NIDEK AFC-230 fundus camera.
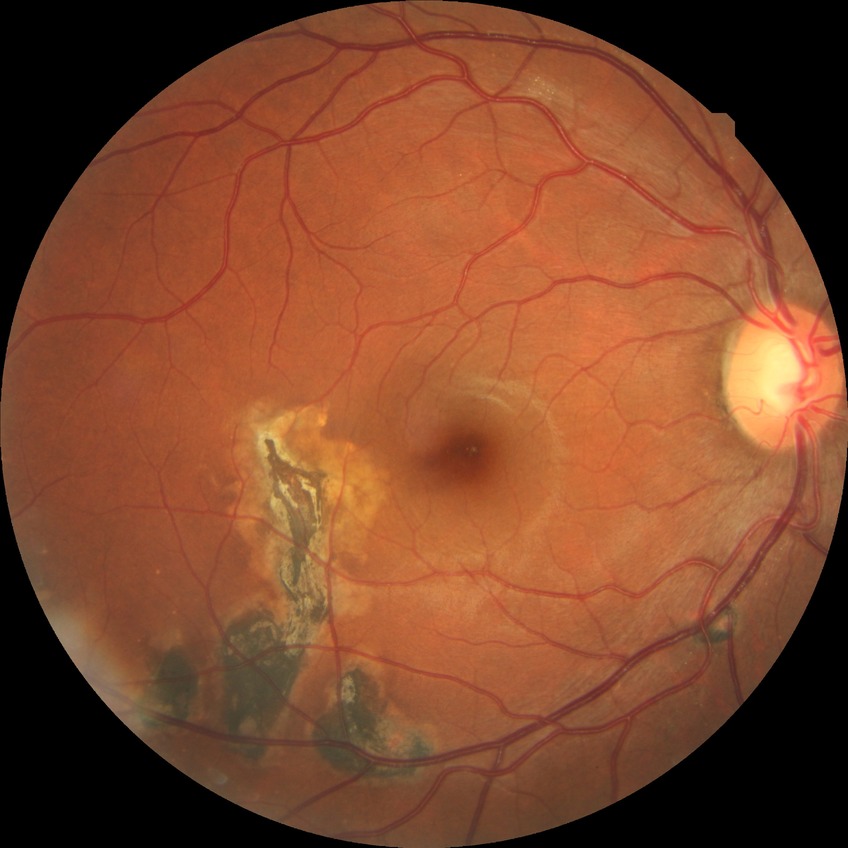 Diabetic retinopathy (DR) is NDR (no diabetic retinopathy).